45° field of view
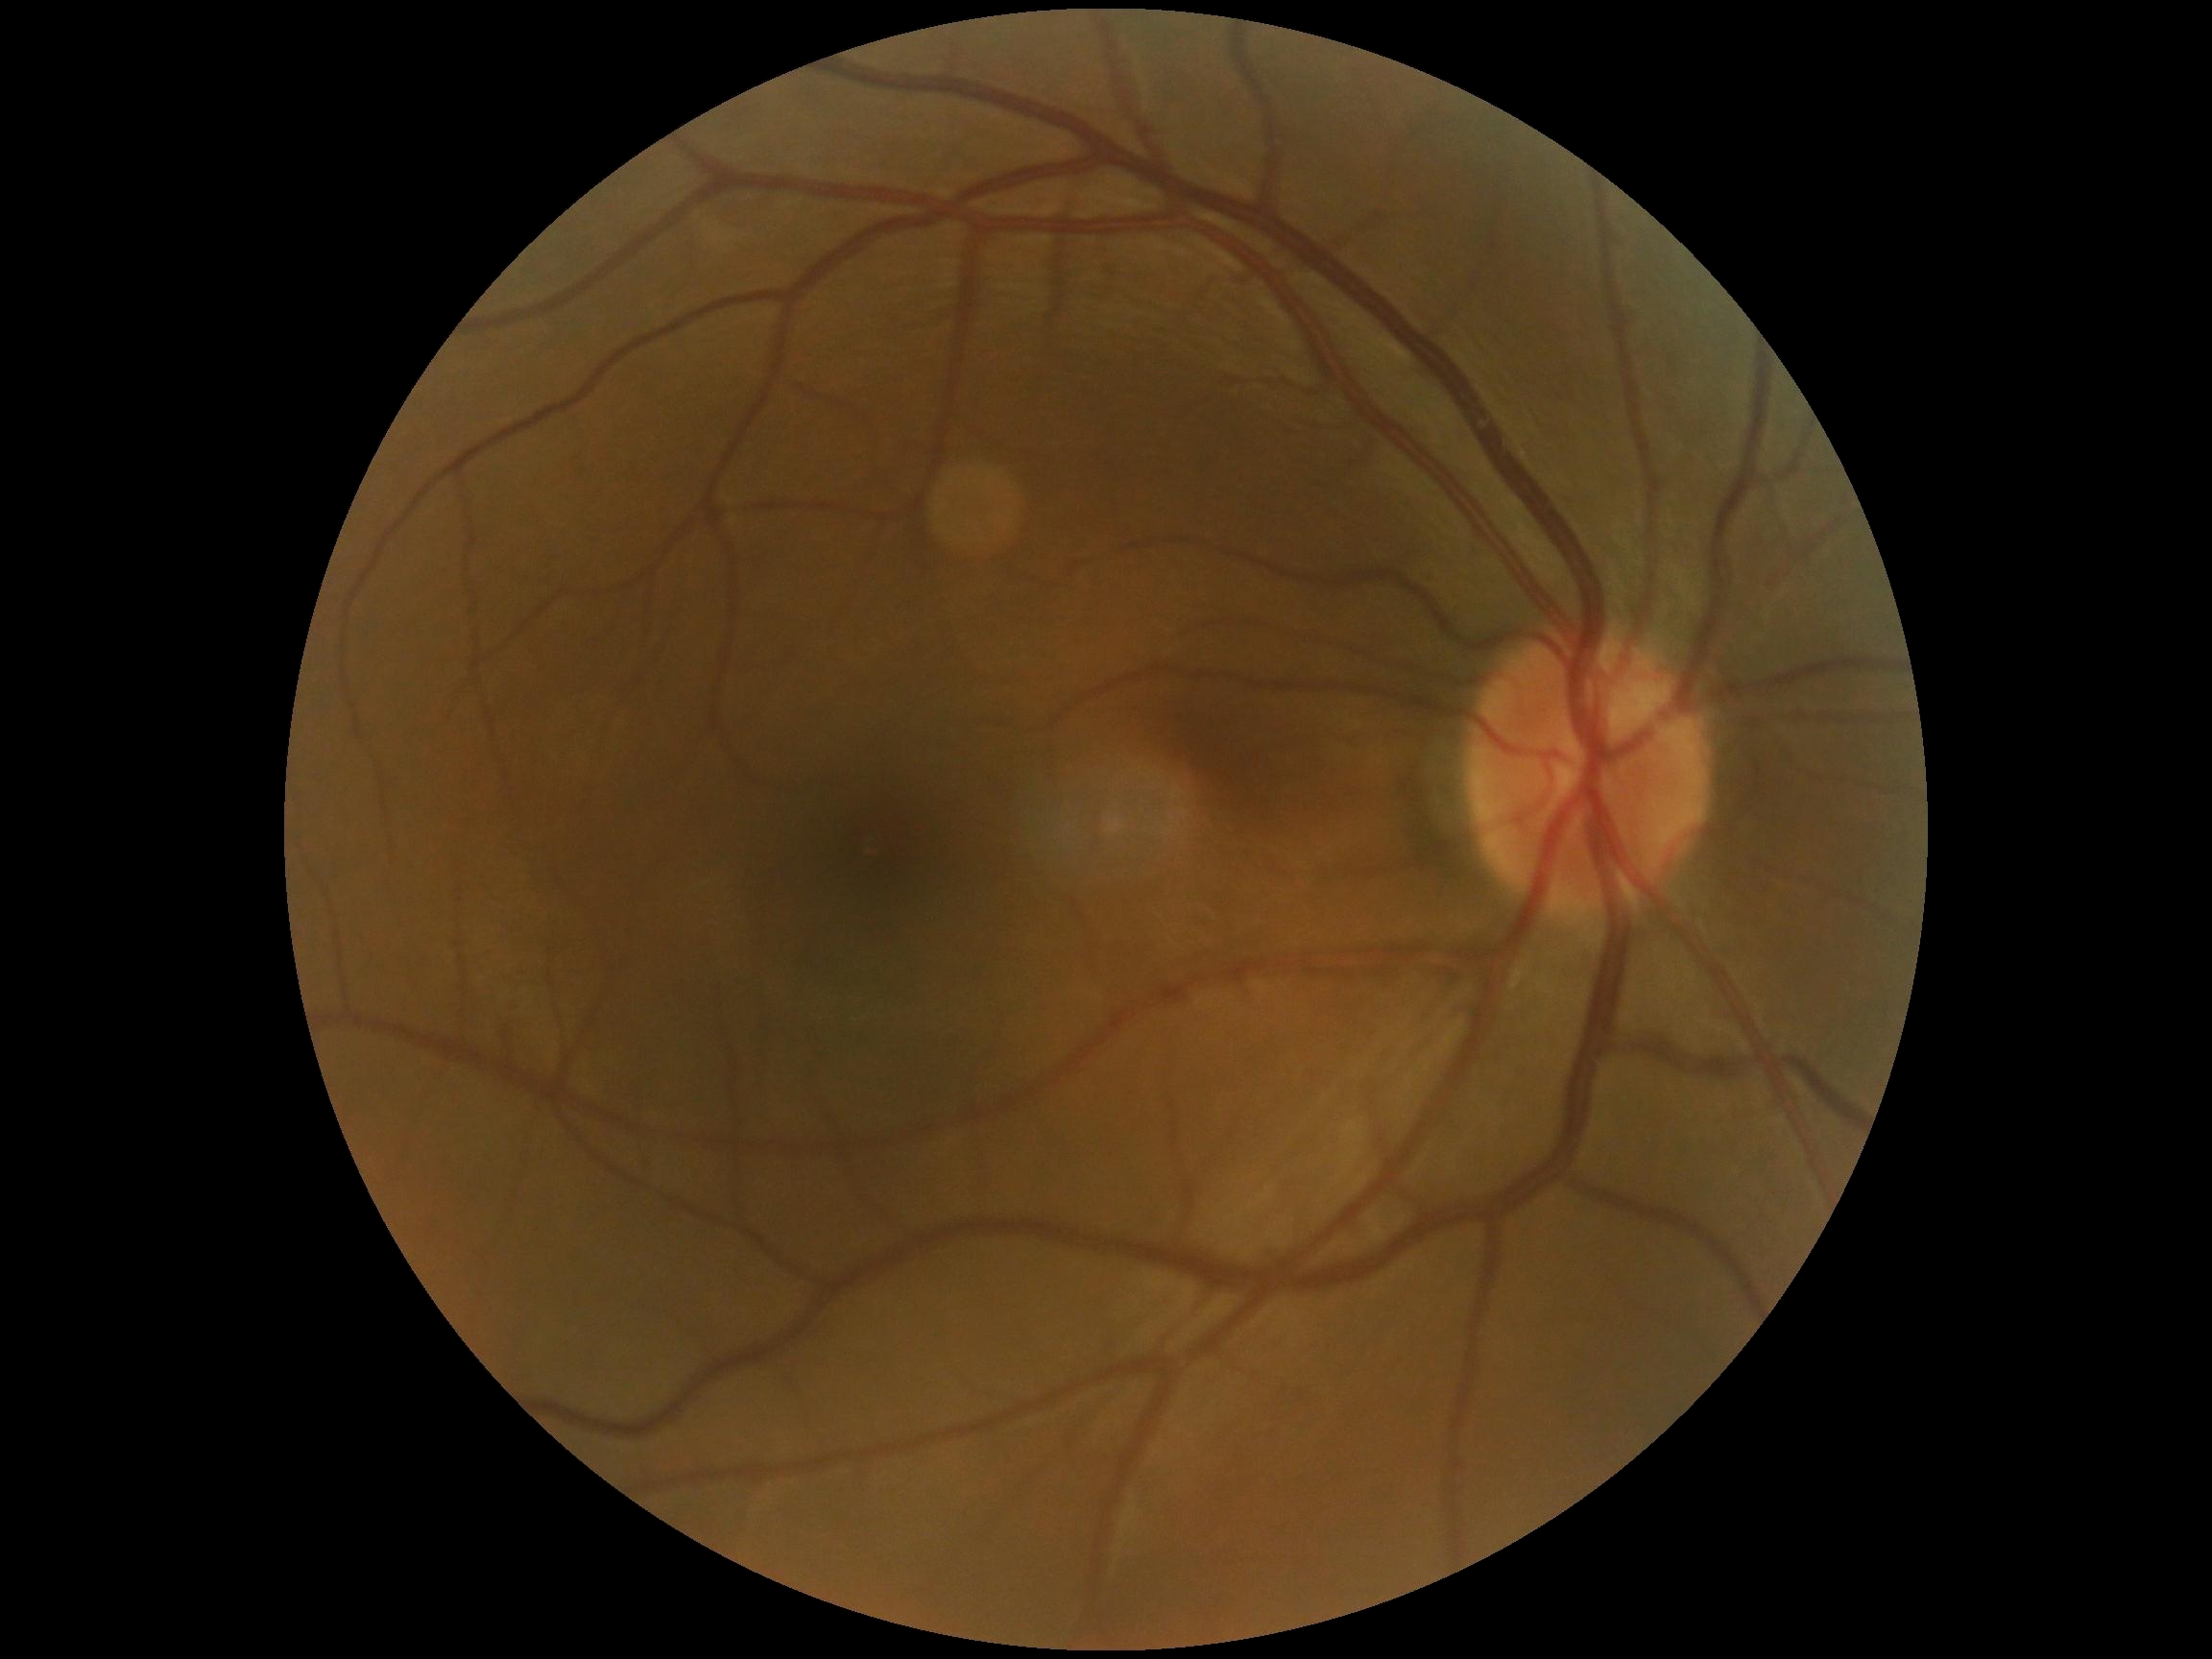 DR severity: 0/4, DR impression: no signs of DR.